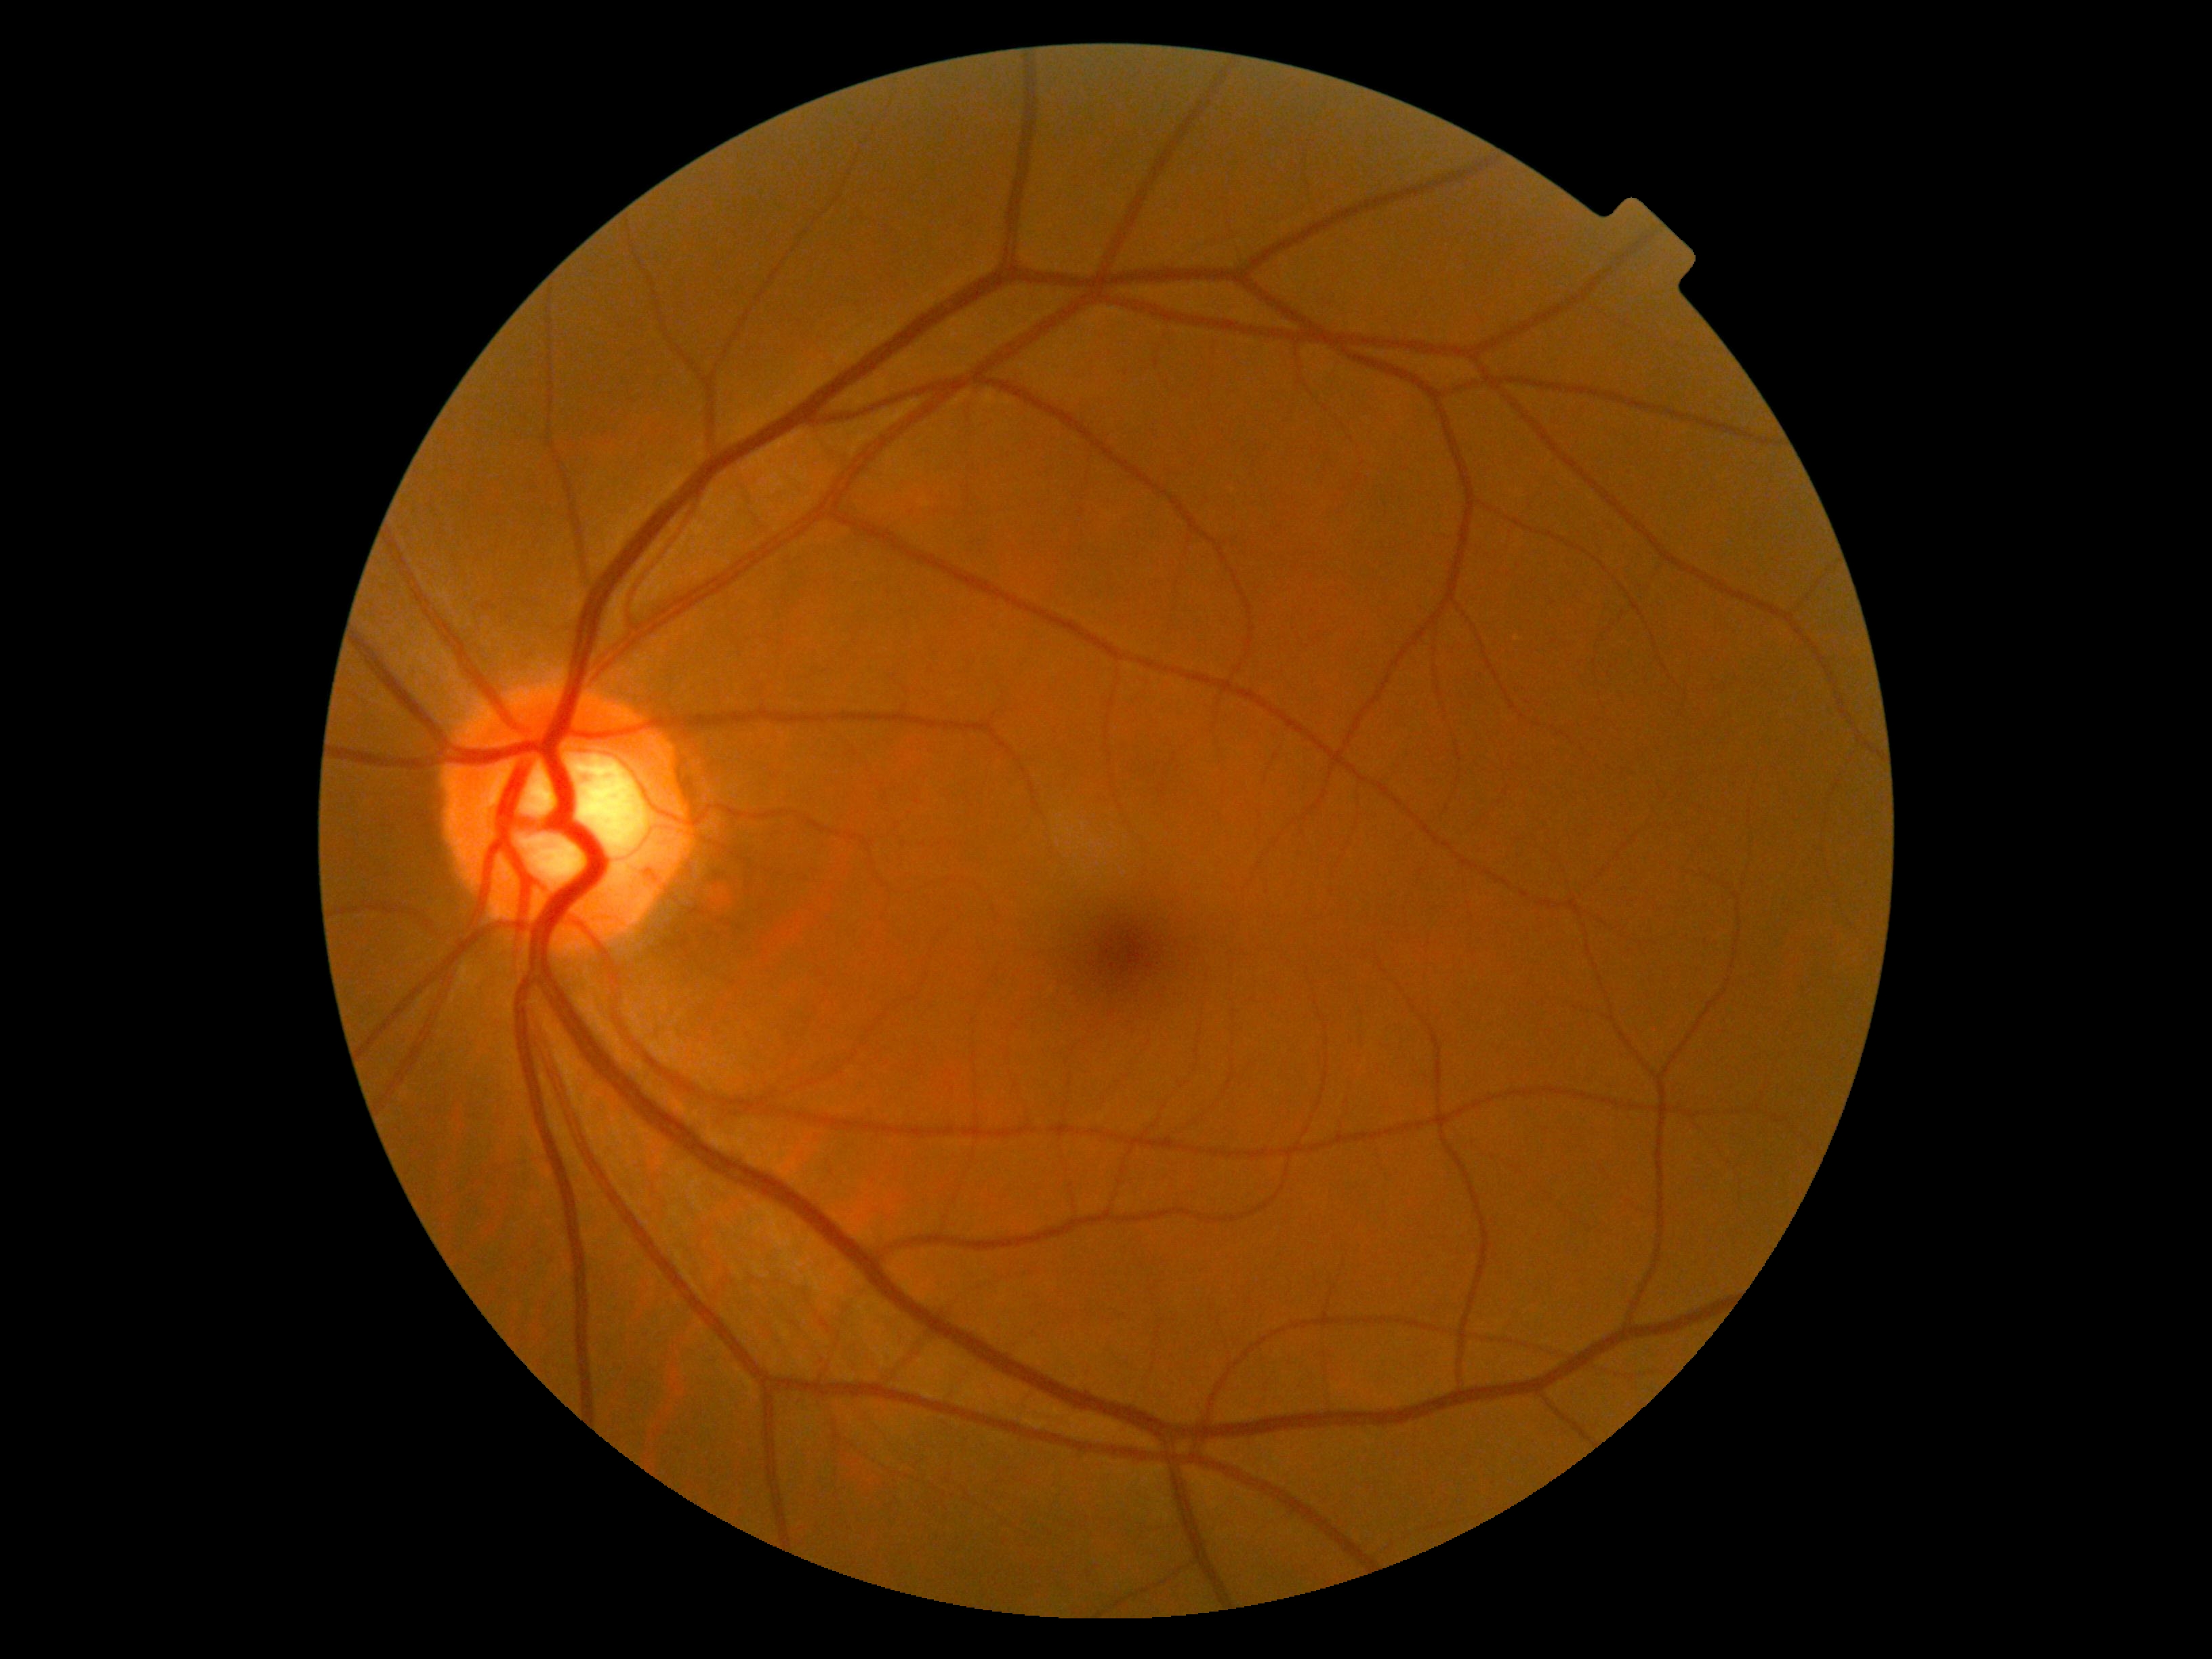

DR grade: 0 (no apparent retinopathy).